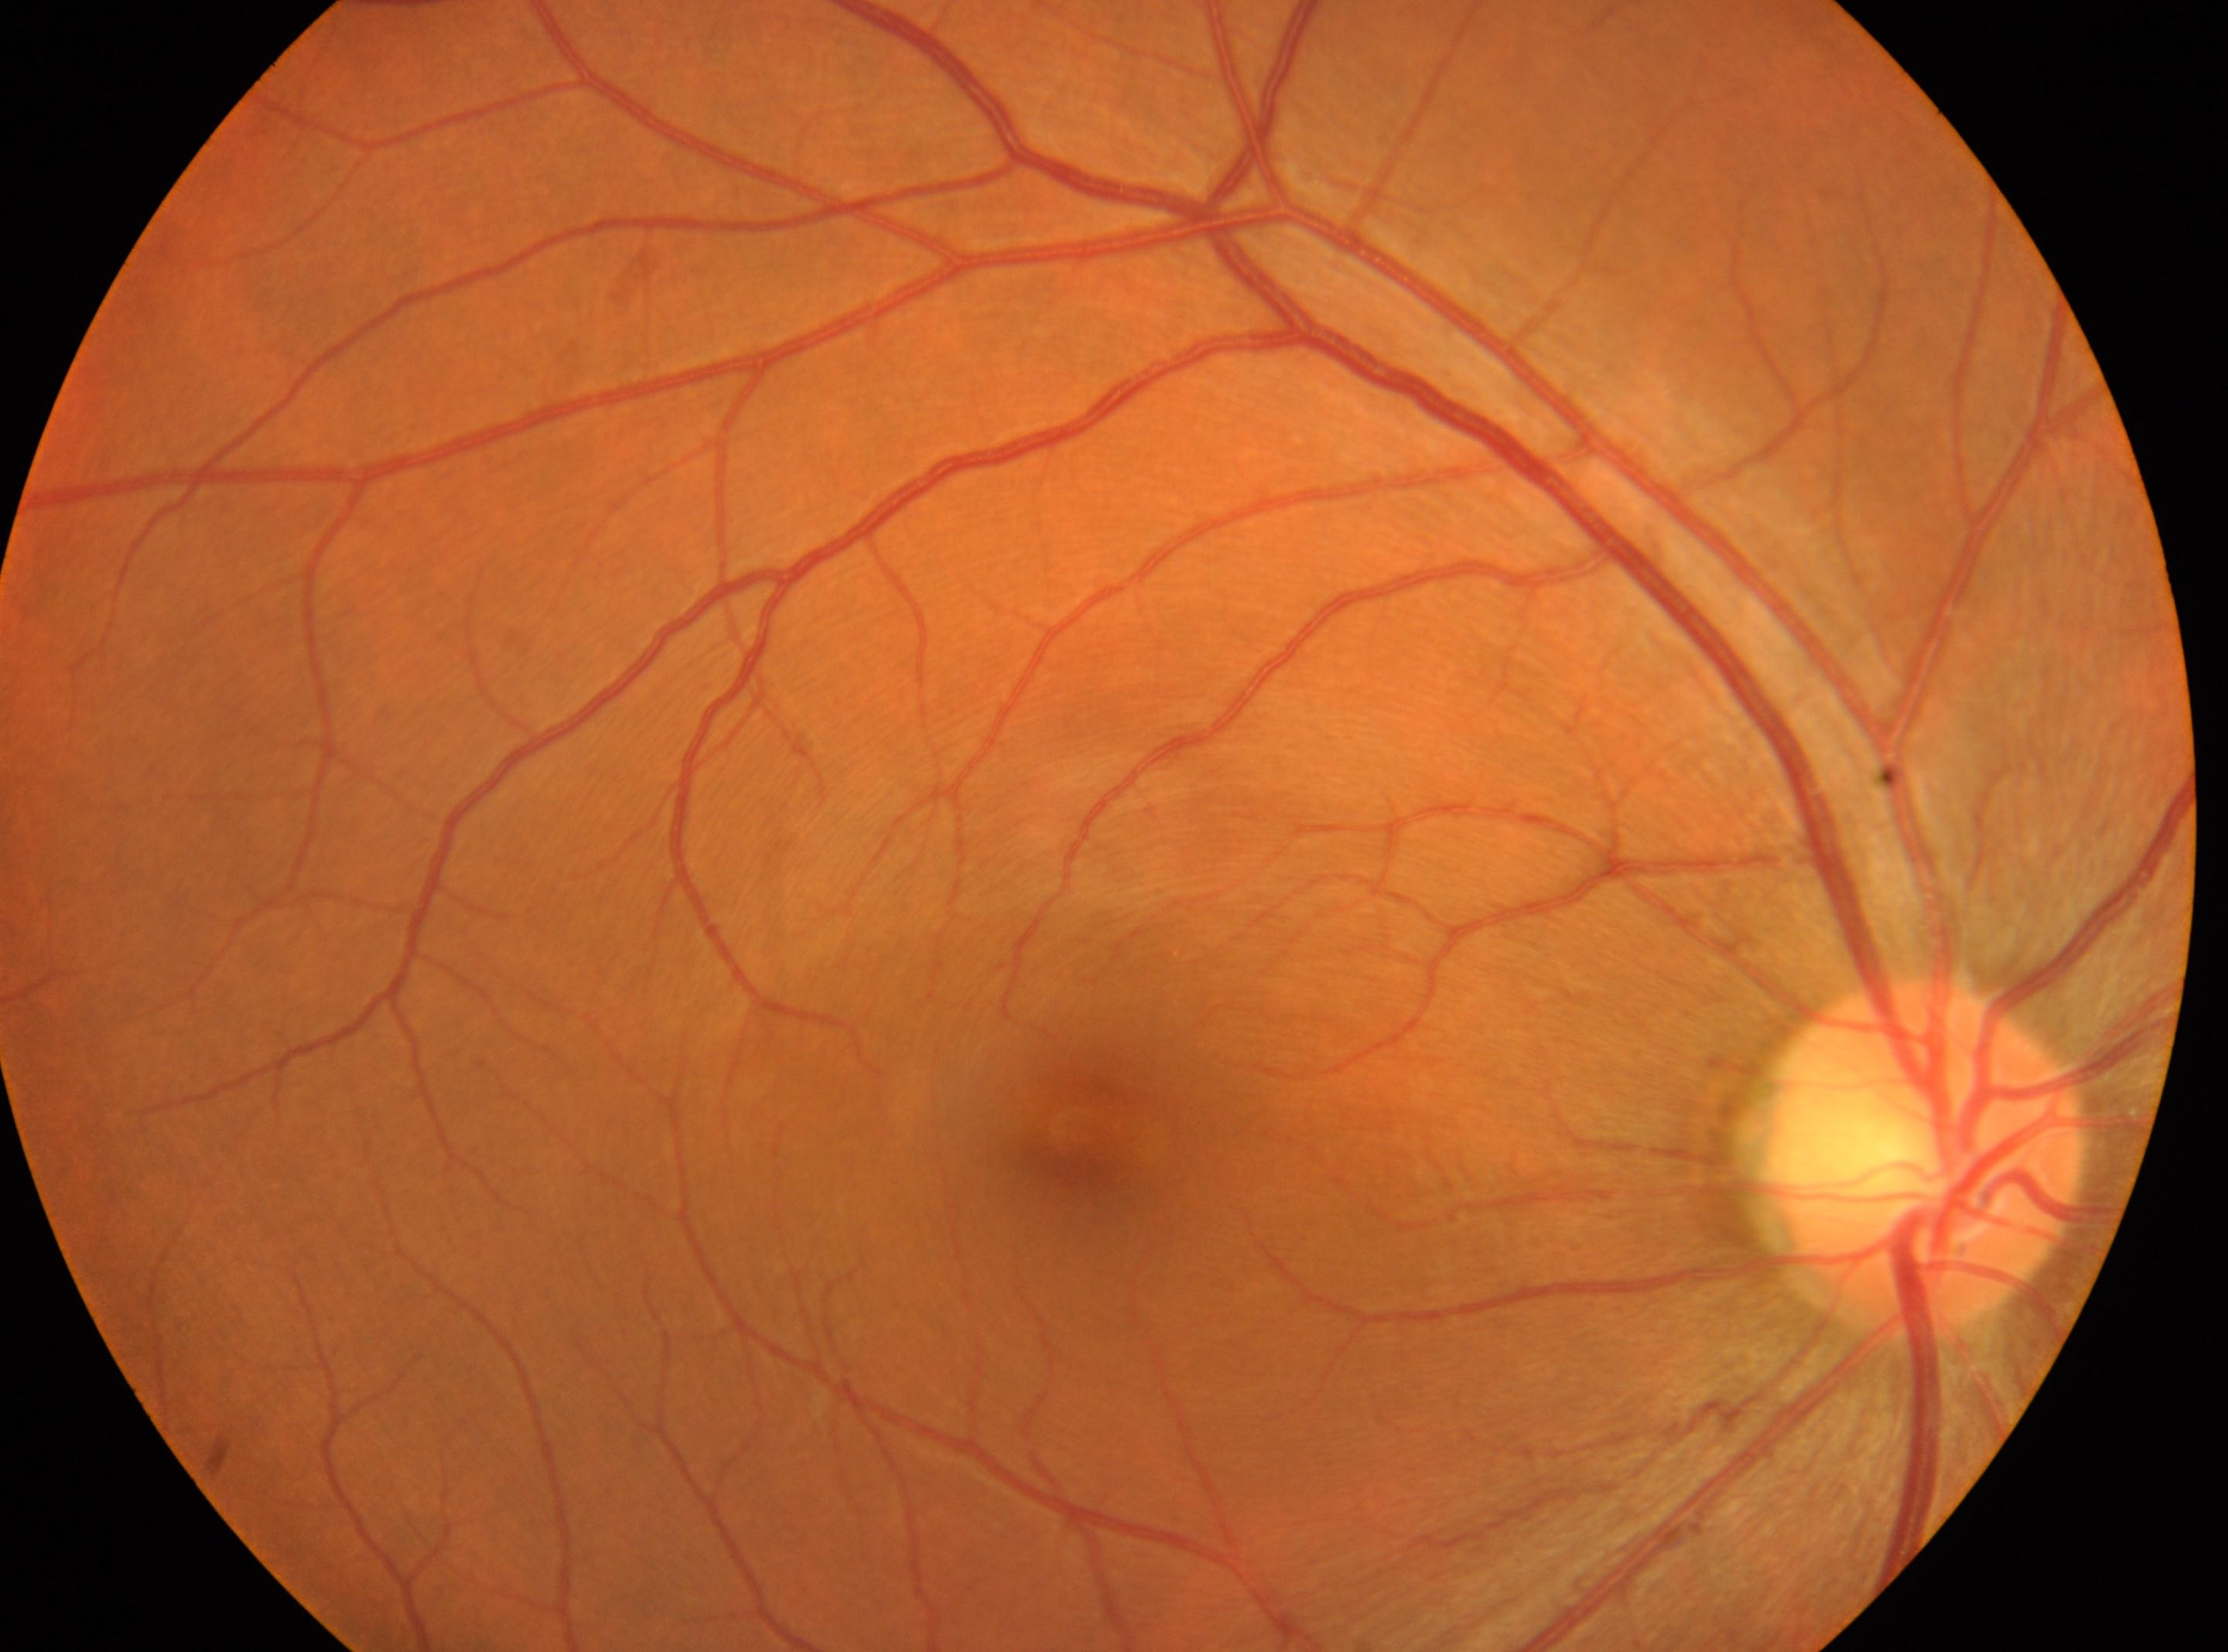
| feature | annotation |
|---|---|
| optic disc | x=1922, y=1152 |
| laterality | the right eye |
| macular center | x=1082, y=1134 |
| DR impression | No signs of diabetic retinopathy |
| DR | no apparent retinopathy (grade 0) |